Acquired with a Nidek AFC-330. 240 x 240 pixels. Retinal fundus photograph:
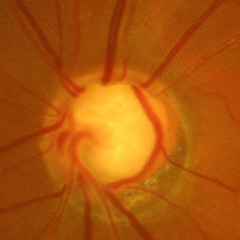

Assessment: advanced glaucoma.